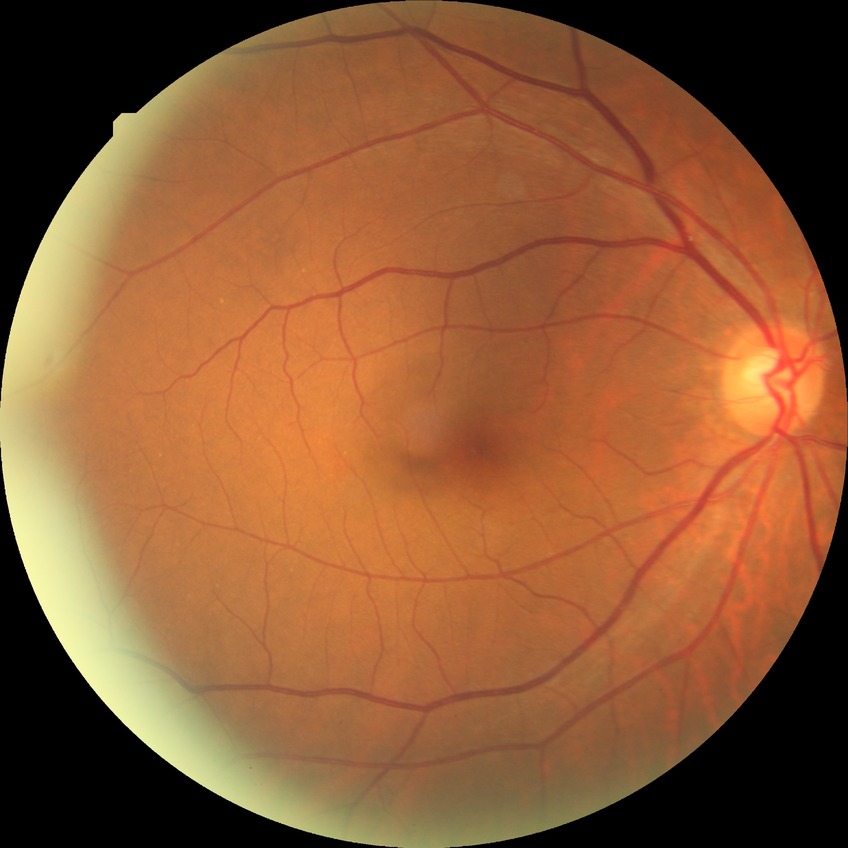

Findings:
• diabetic retinopathy (DR) — no diabetic retinopathy (NDR)